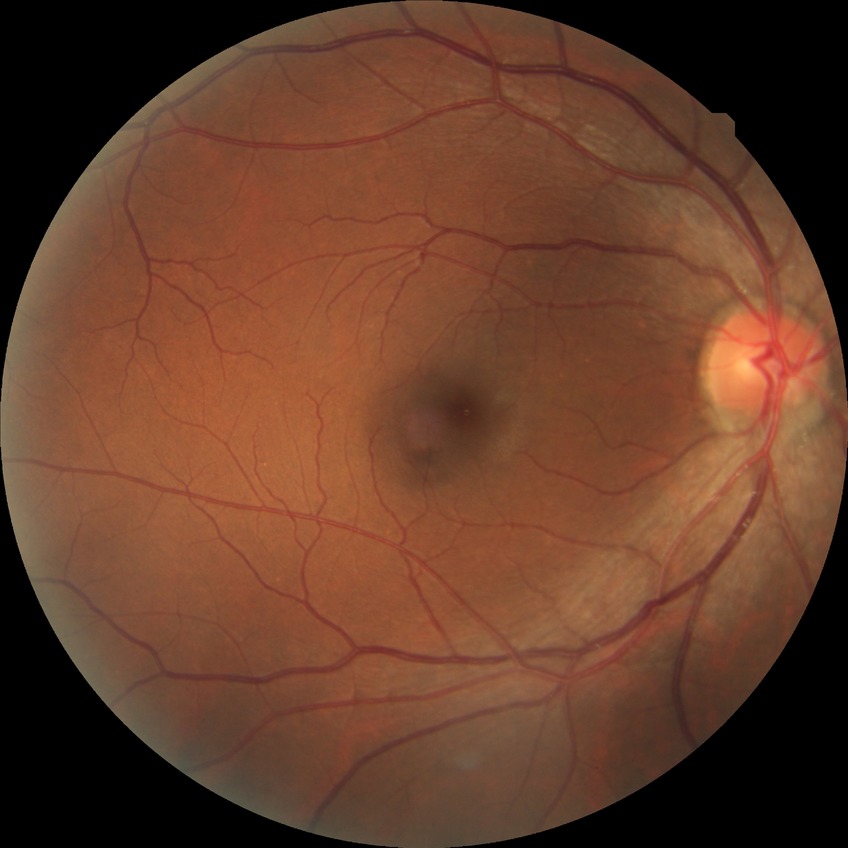

diabetic retinopathy severity: no diabetic retinopathy.